Infant wide-field fundus photograph — 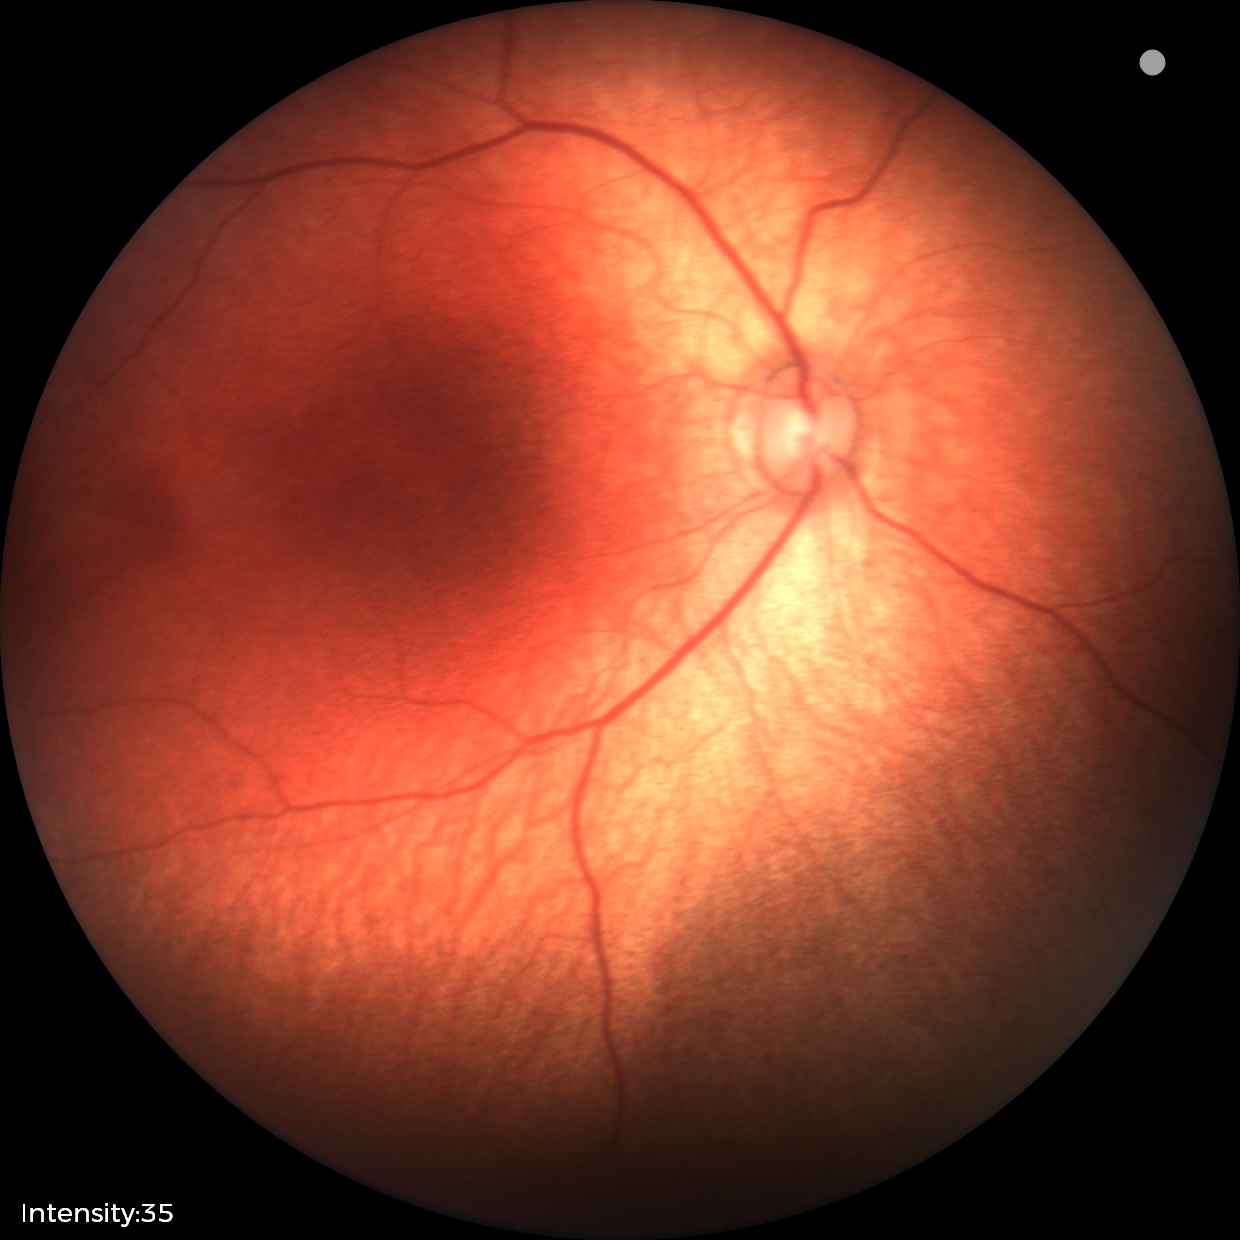 Normal screening examination.